Modified Davis grading.
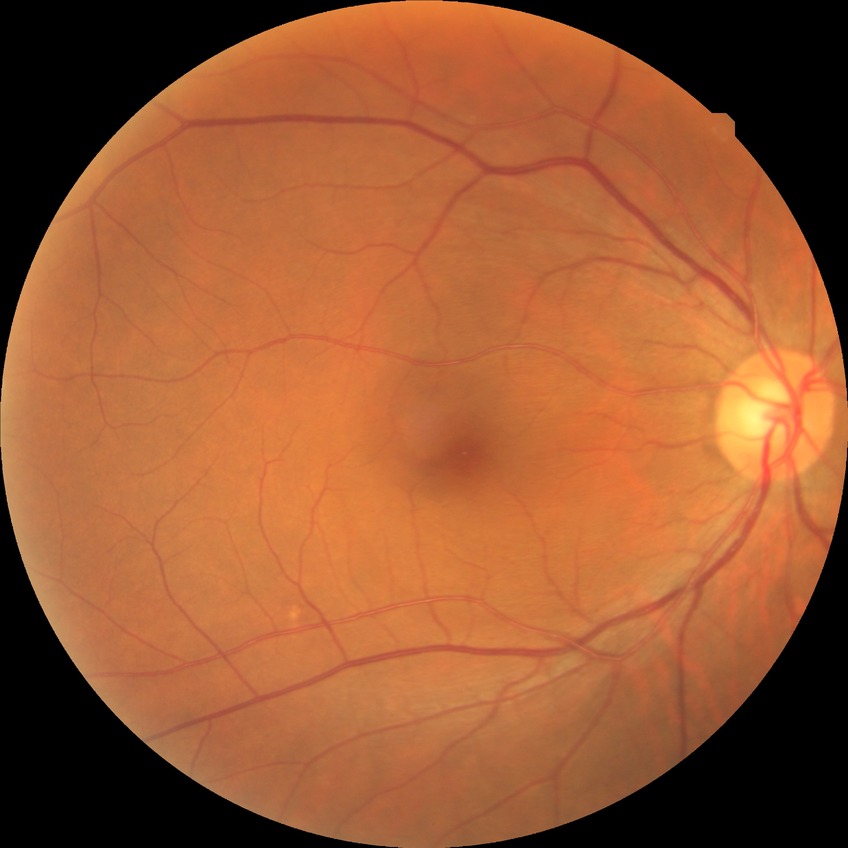
{
  "davis_grade": "NDR",
  "dr_impression": "no apparent DR"
}